848 x 848 pixels
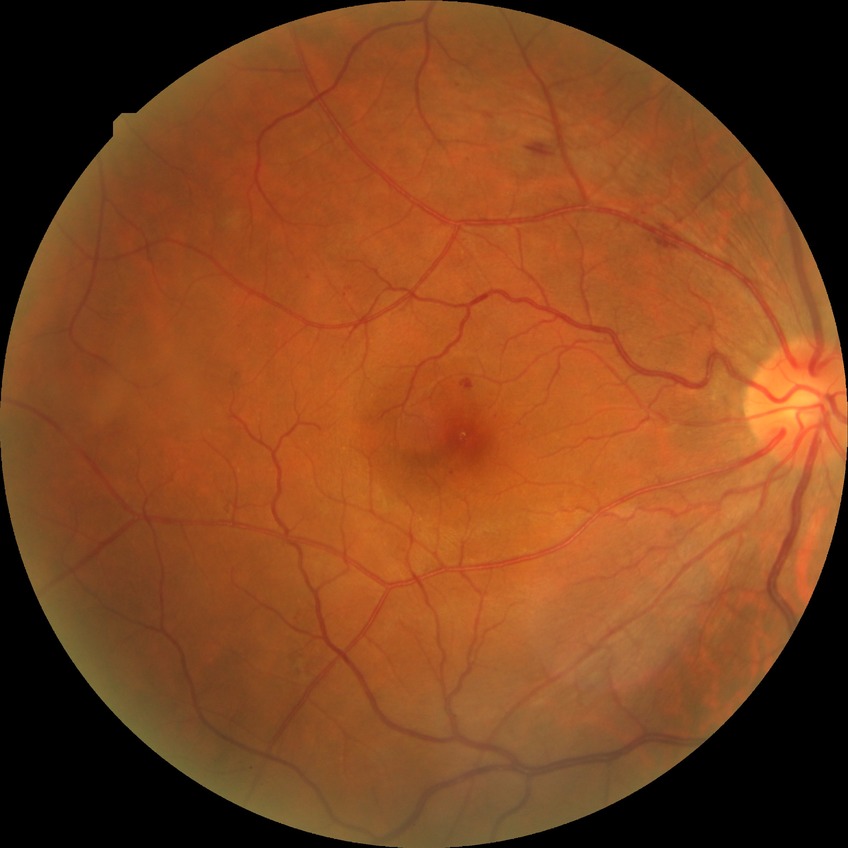

  davis_grade: simple diabetic retinopathy
  proliferative_class: non-proliferative diabetic retinopathy